Wide-field fundus photograph of an infant · image size 640x480 — 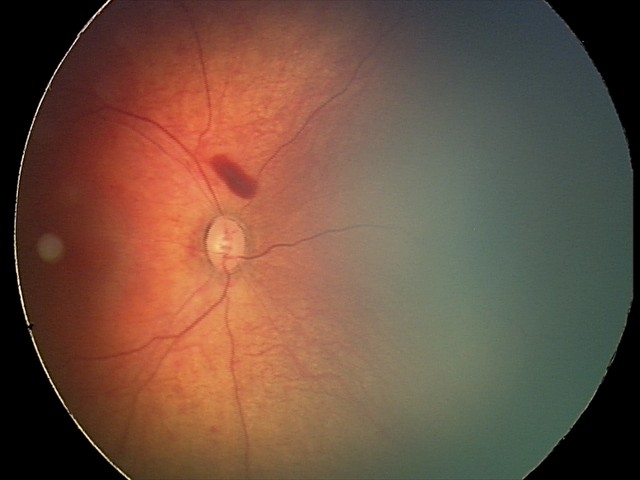 Examination diagnosed as retinal hemorrhages.